Nonmydriatic; color fundus image: 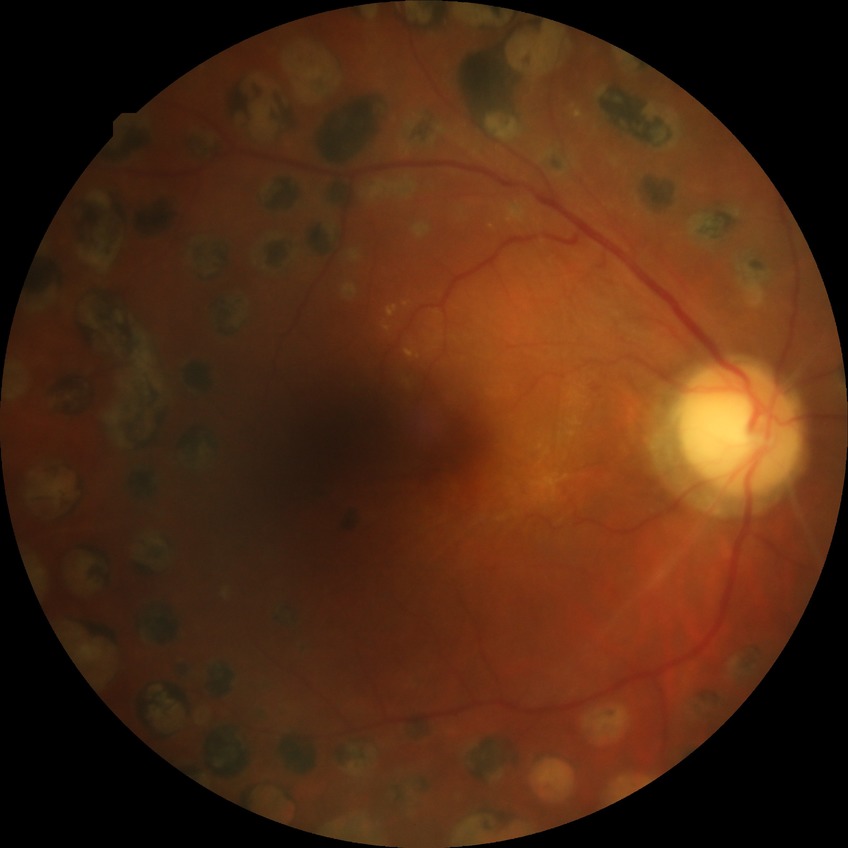
Annotations:
* diabetic retinopathy (DR): PDR (proliferative diabetic retinopathy)